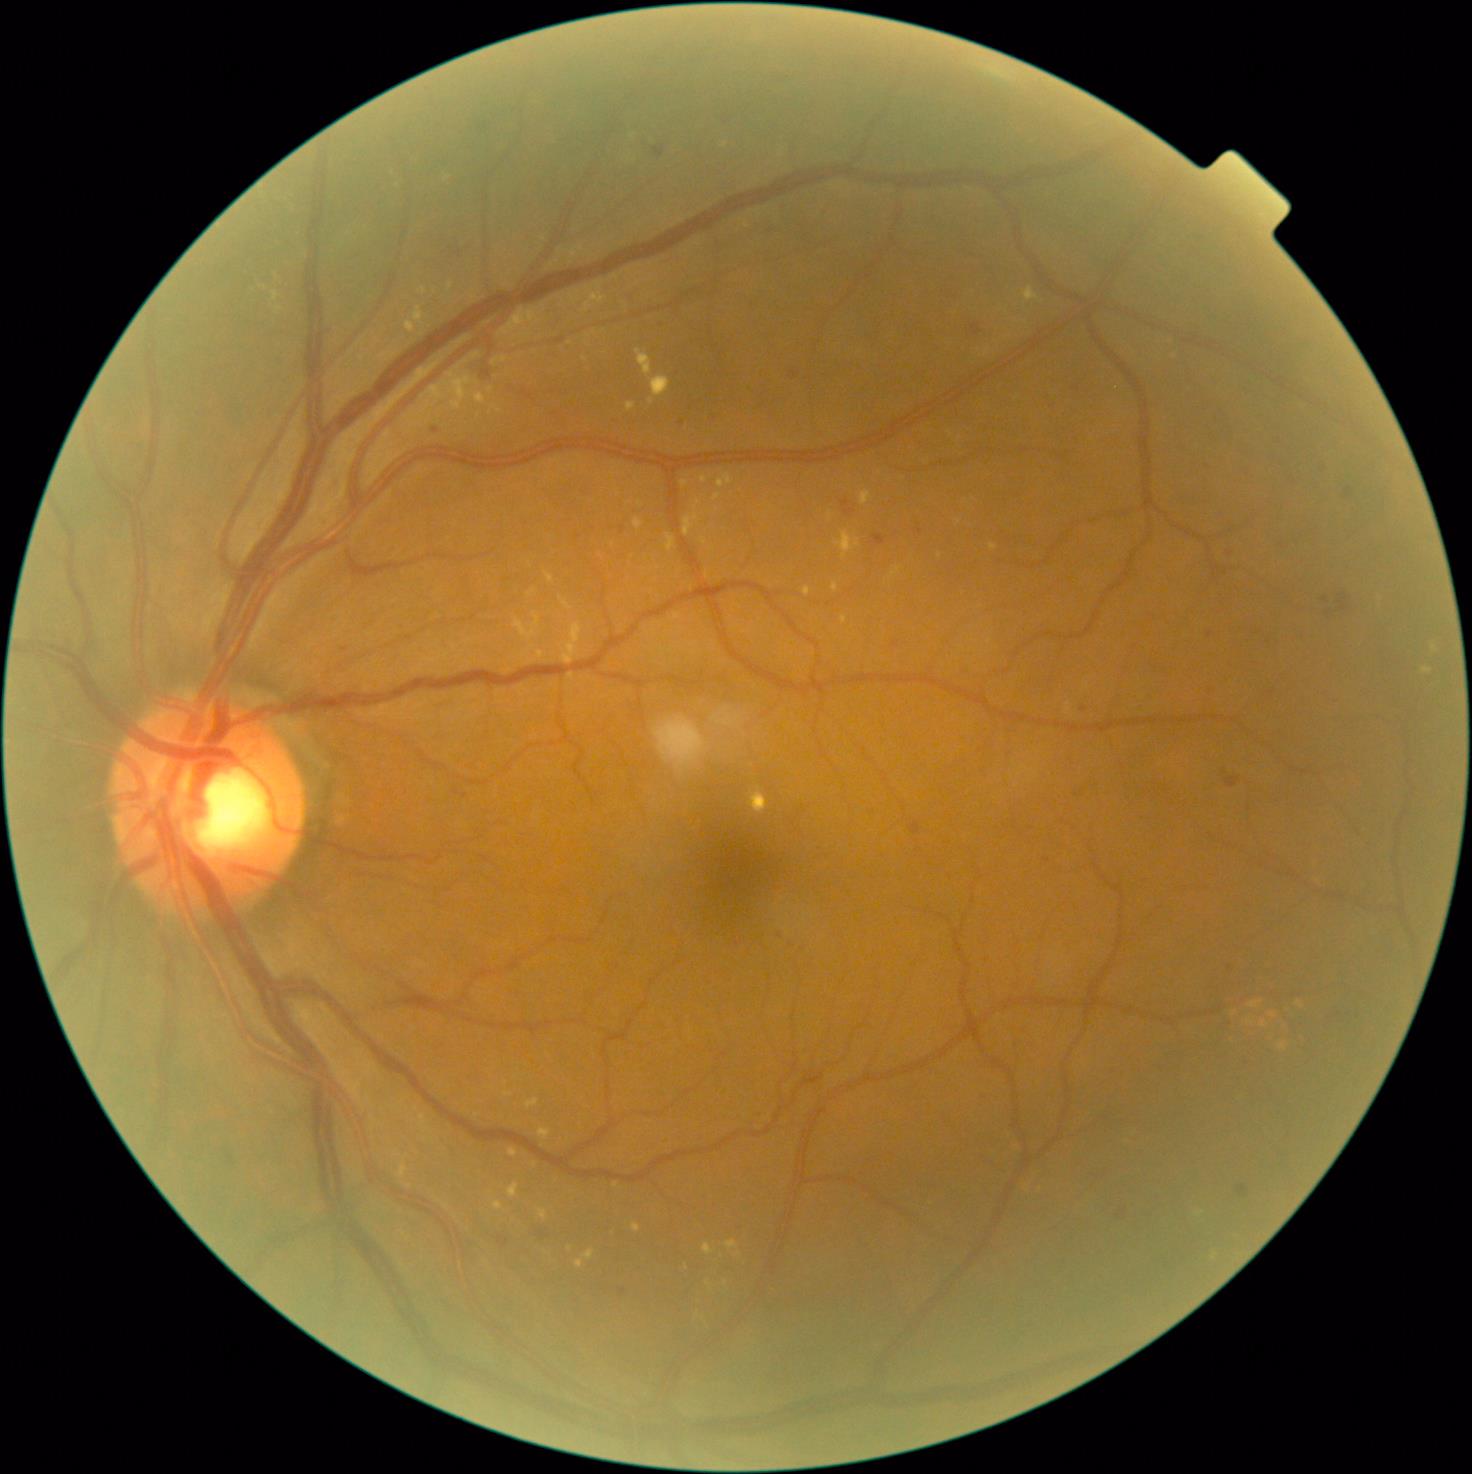 DR grade is 2 (moderate NPDR).
EXs are present, including at box=[539, 1208, 548, 1220], box=[651, 376, 671, 398], box=[701, 538, 707, 546], box=[718, 474, 733, 488], box=[632, 1223, 641, 1233], box=[1248, 1000, 1264, 1009], box=[499, 307, 540, 336], box=[1261, 1020, 1269, 1028], box=[704, 1243, 715, 1255].
Smaller EXs around <point>725, 145</point>, <point>1234, 1013</point>, <point>640, 503</point>, <point>1250, 1022</point>, <point>684, 484</point>, <point>959, 521</point>, <point>617, 1185</point>.